848 by 848 pixels:
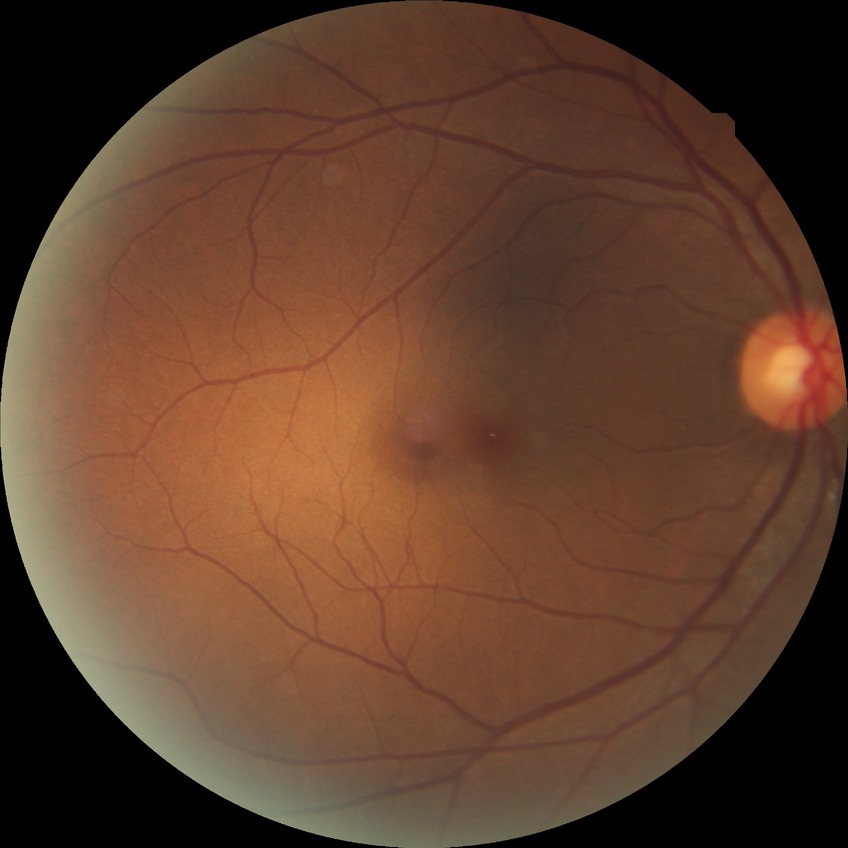
Findings:
* diabetic retinopathy stage: no diabetic retinopathy